200-degree field of view · wide-field retinal mosaic image:
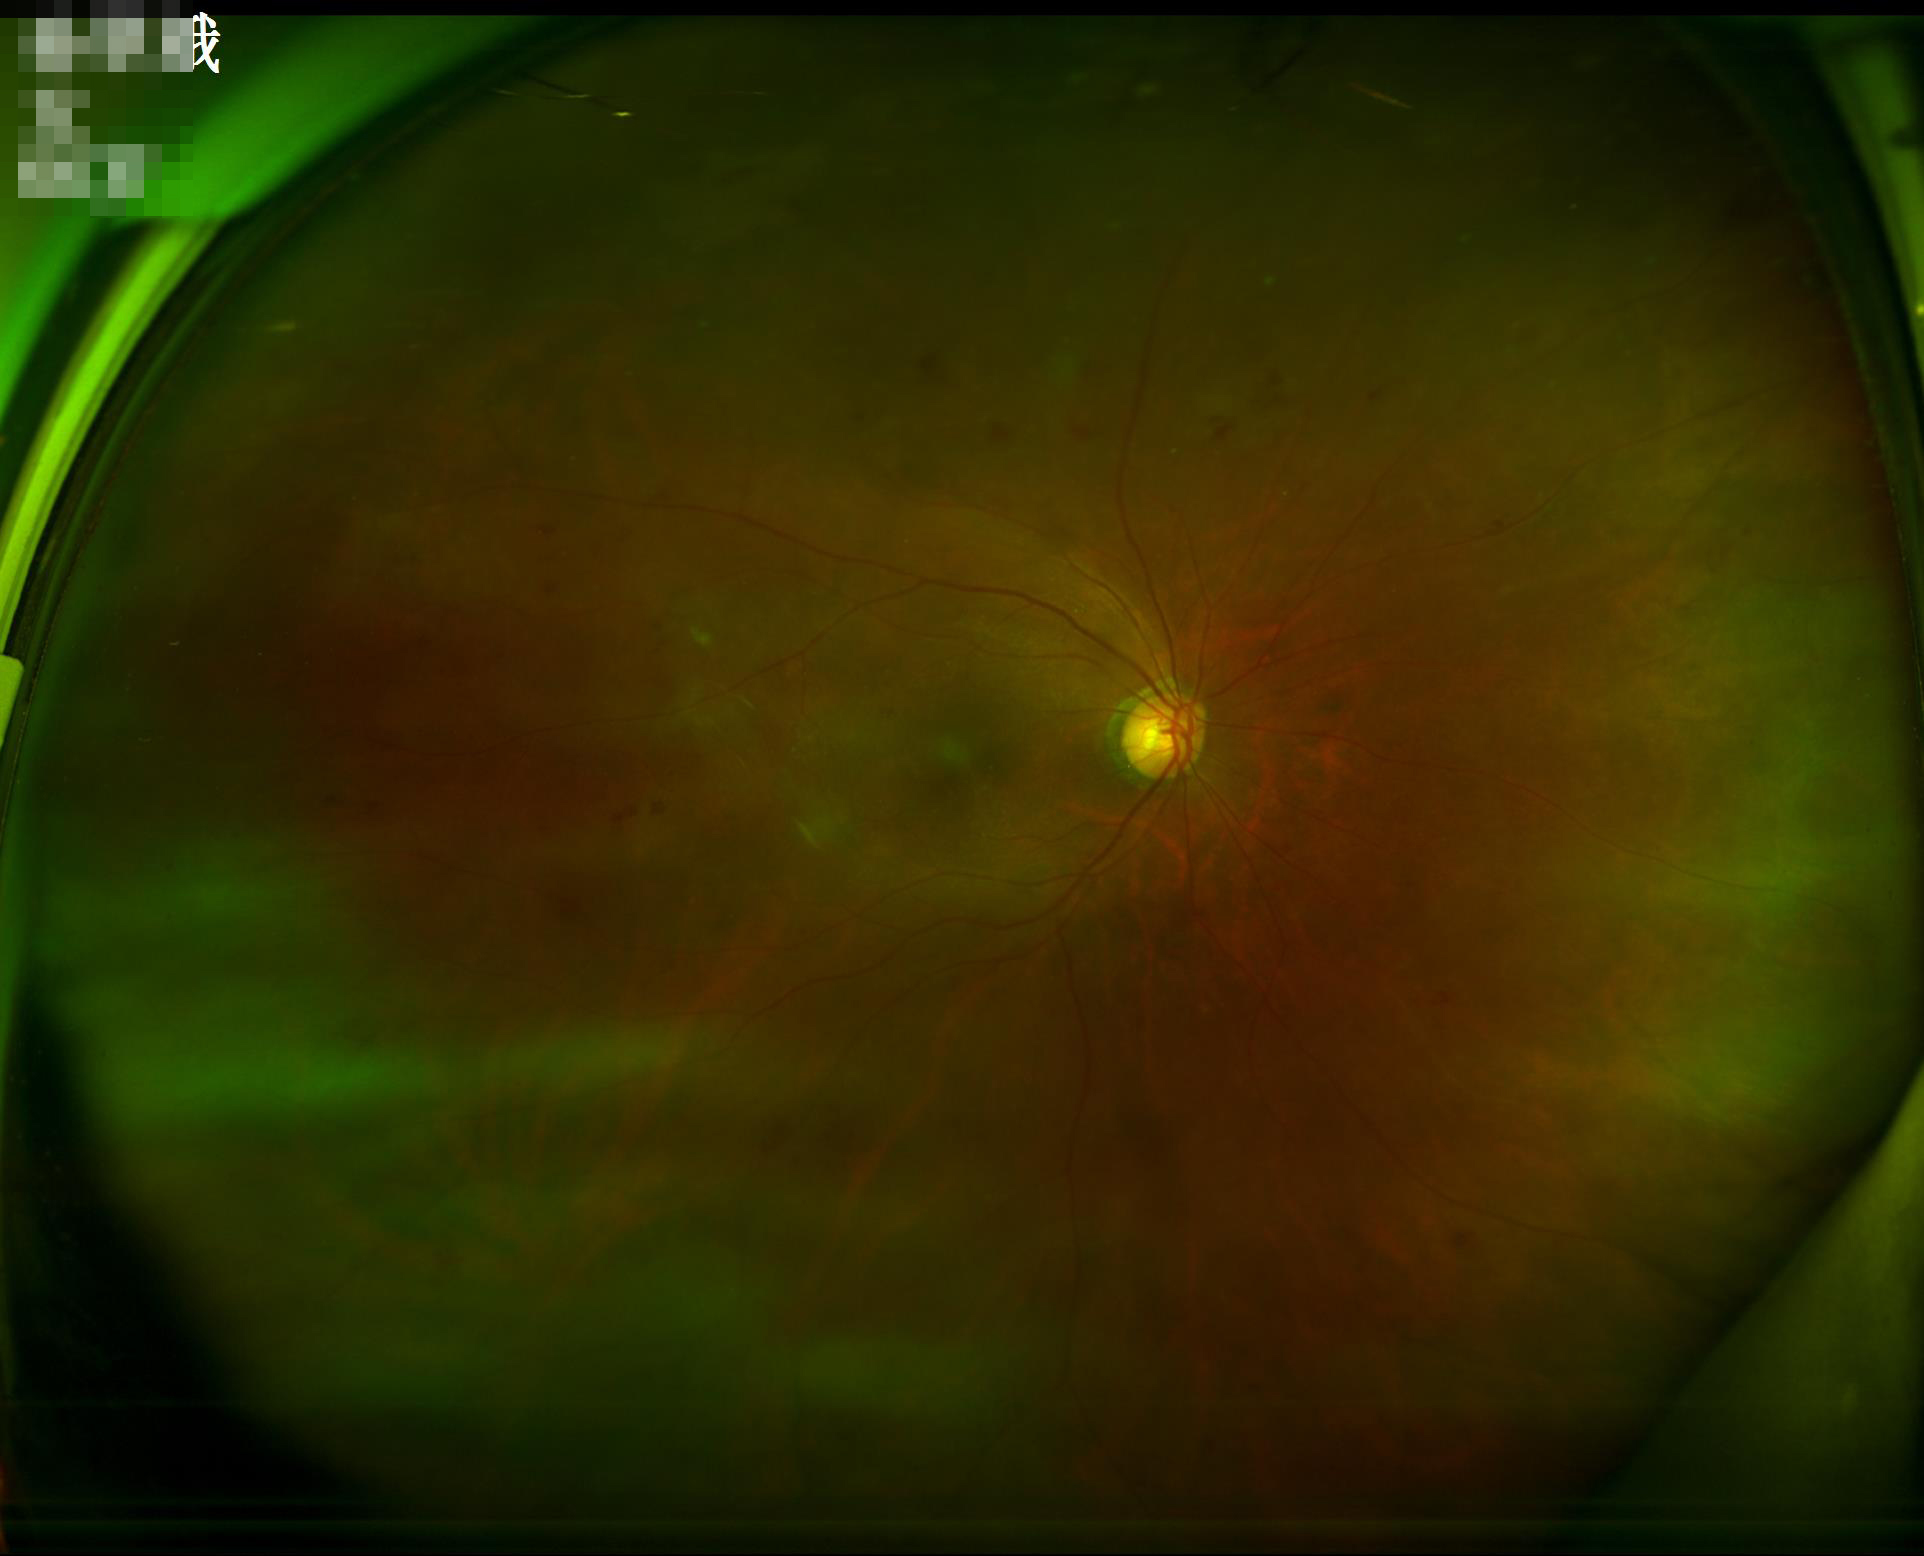
Image quality is inadequate for diagnostic use.
Adequate contrast for distinguishing structures.
Even illumination with no color cast.
Noticeable blur in the optic disc, vessels, or background.